45° field of view — 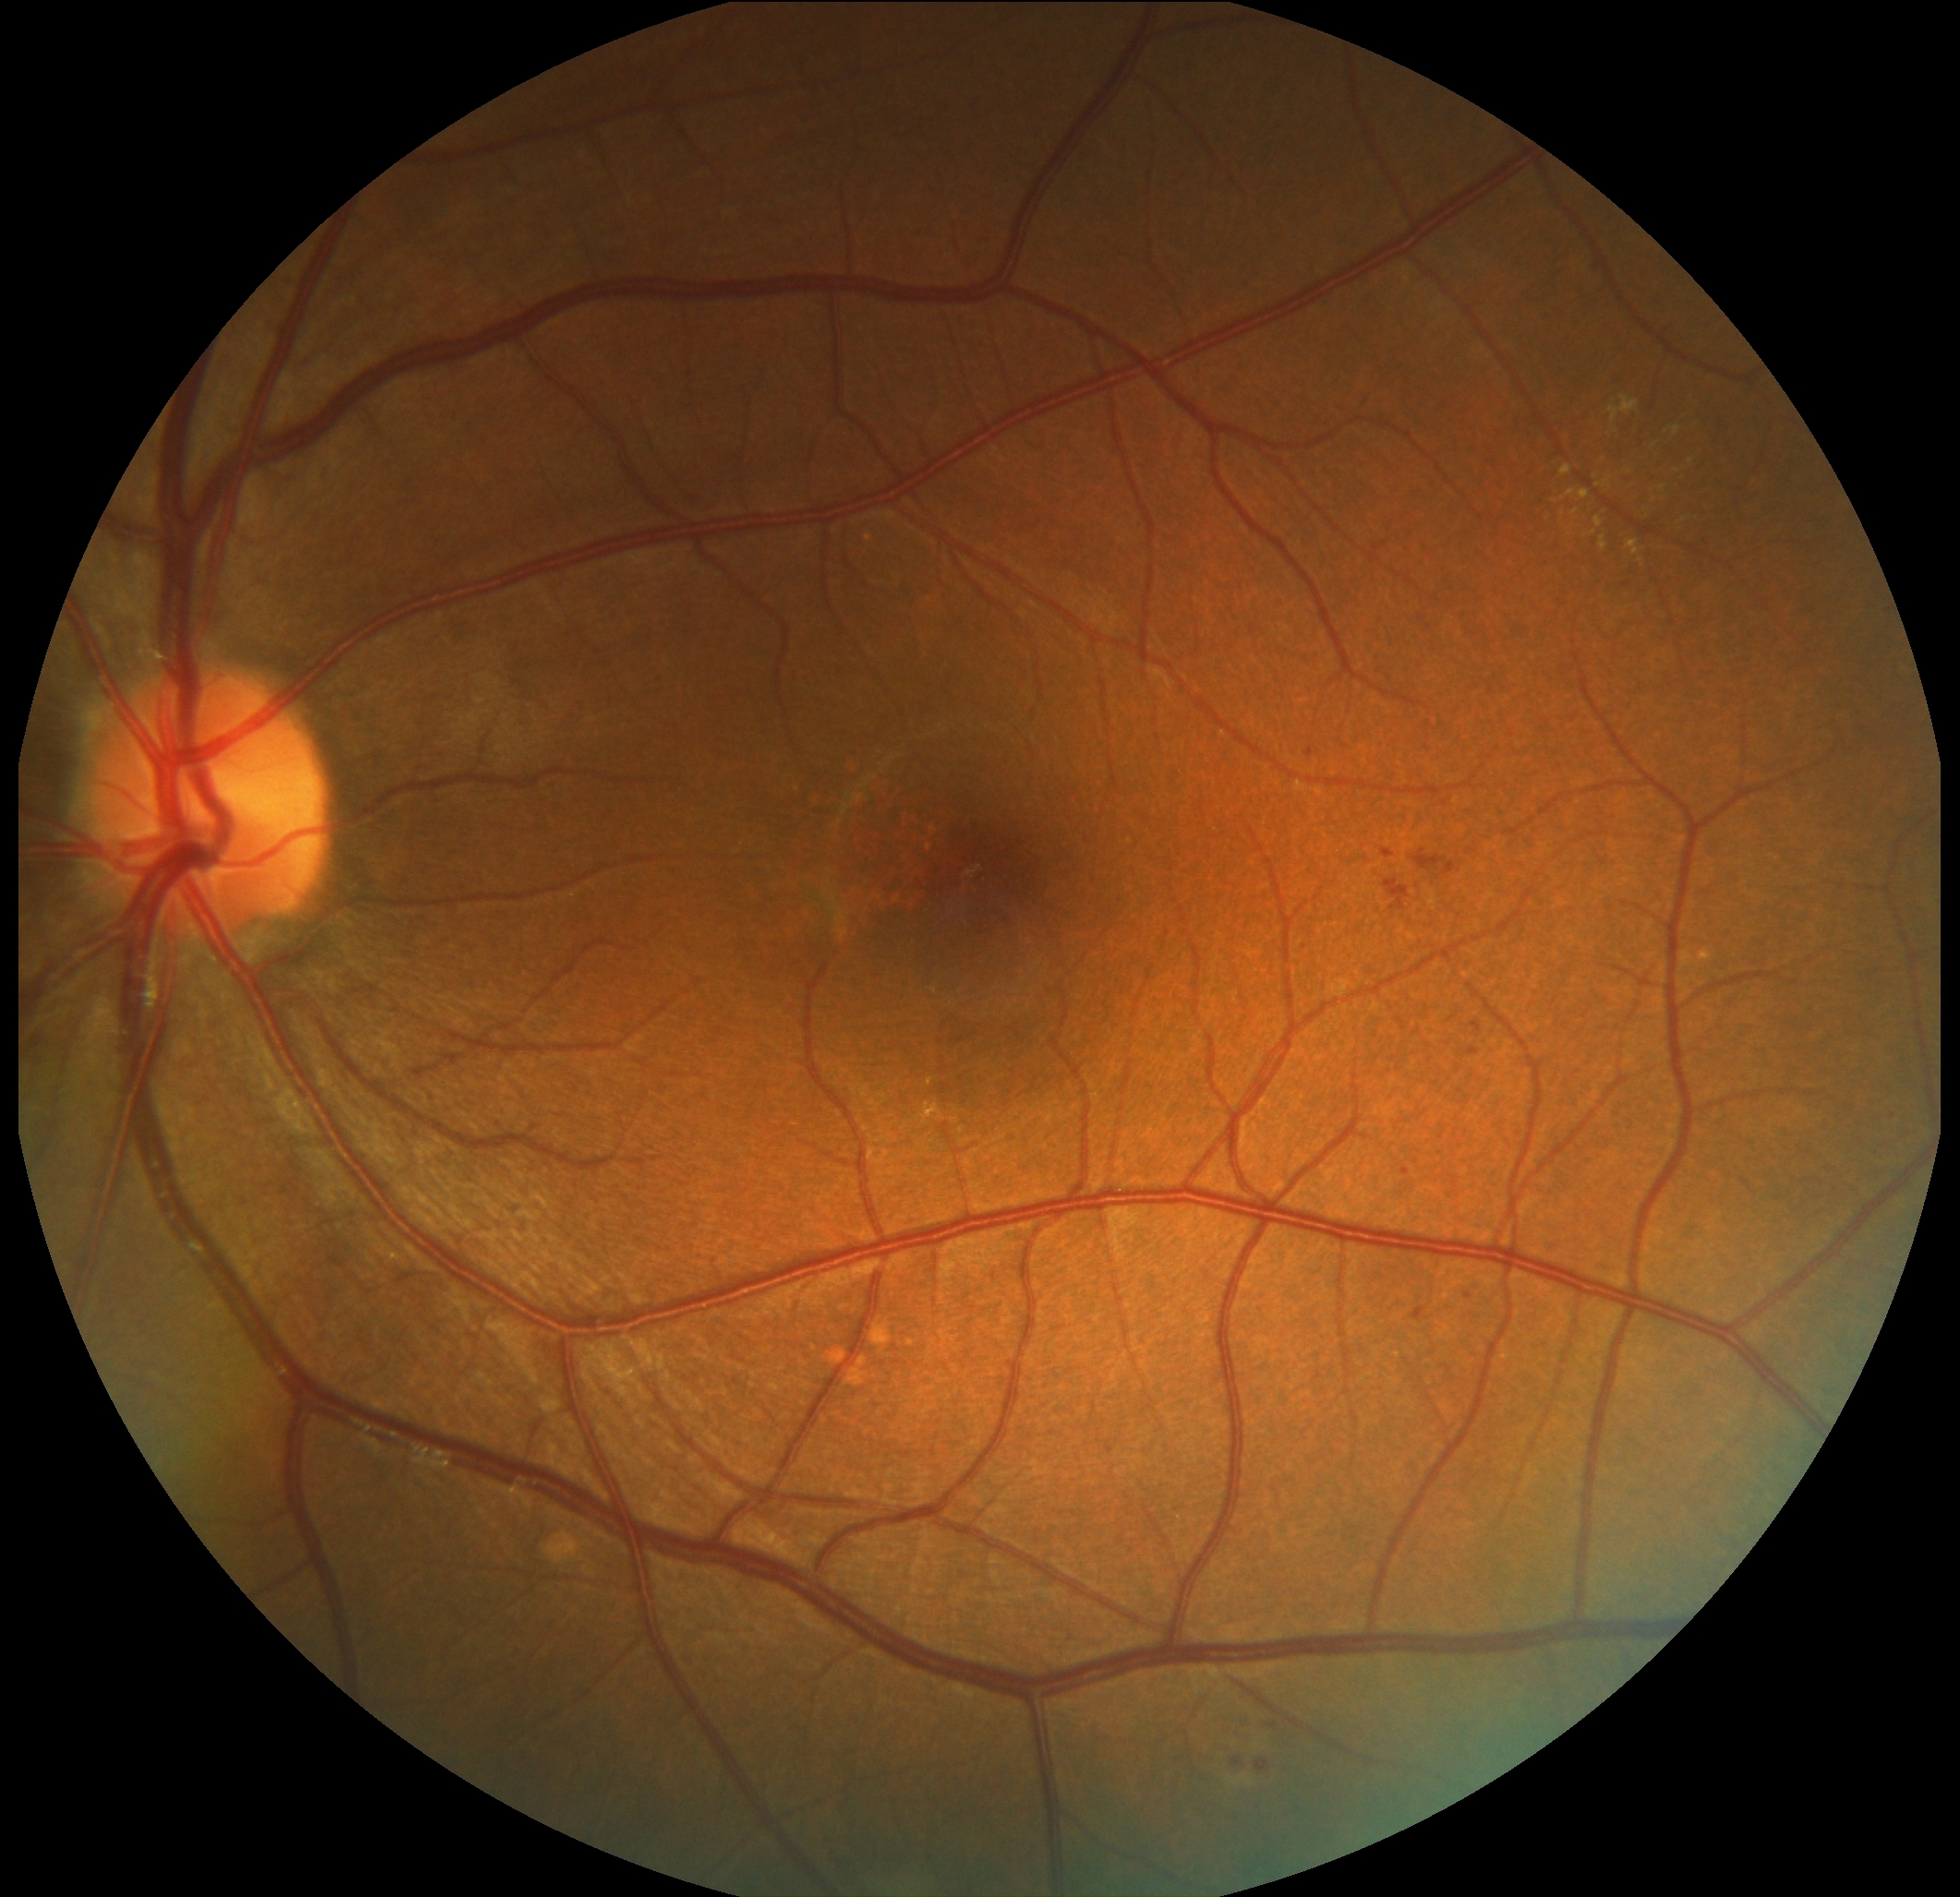

retinopathy grade: 2 (moderate NPDR).